240 x 240 pixels, non-mydriatic fundus camera: 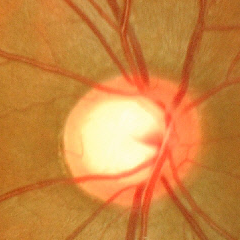 This fundus photograph shows advanced-stage glaucoma.